1504x1000px:
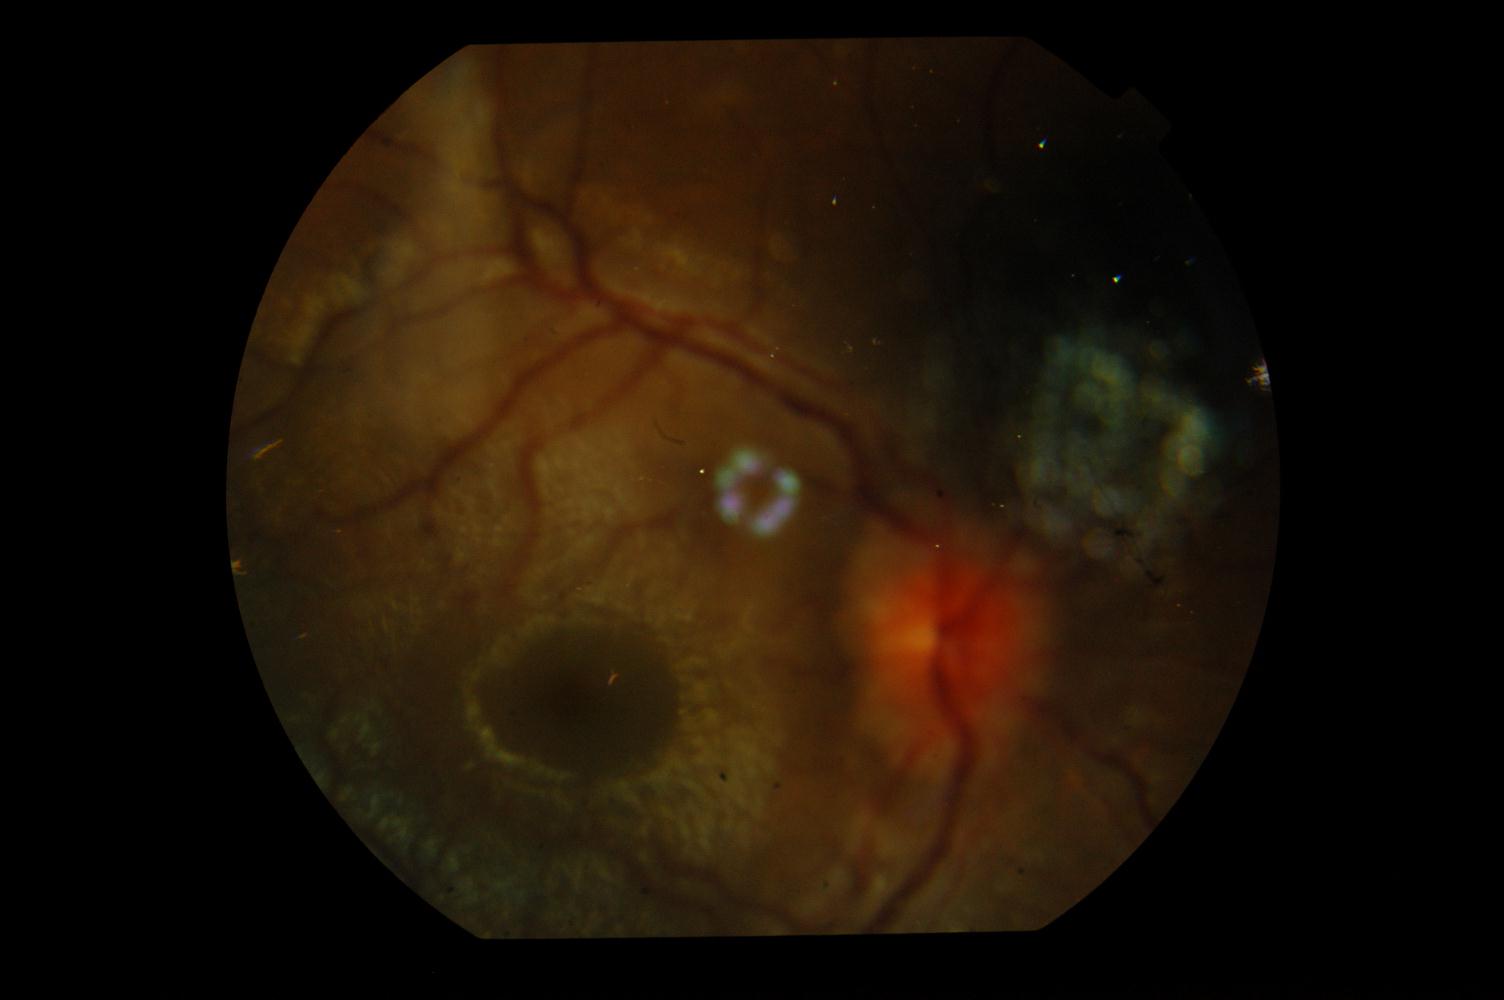

Retinal fundus photograph demonstrating idiopathic intracranial hypertension.